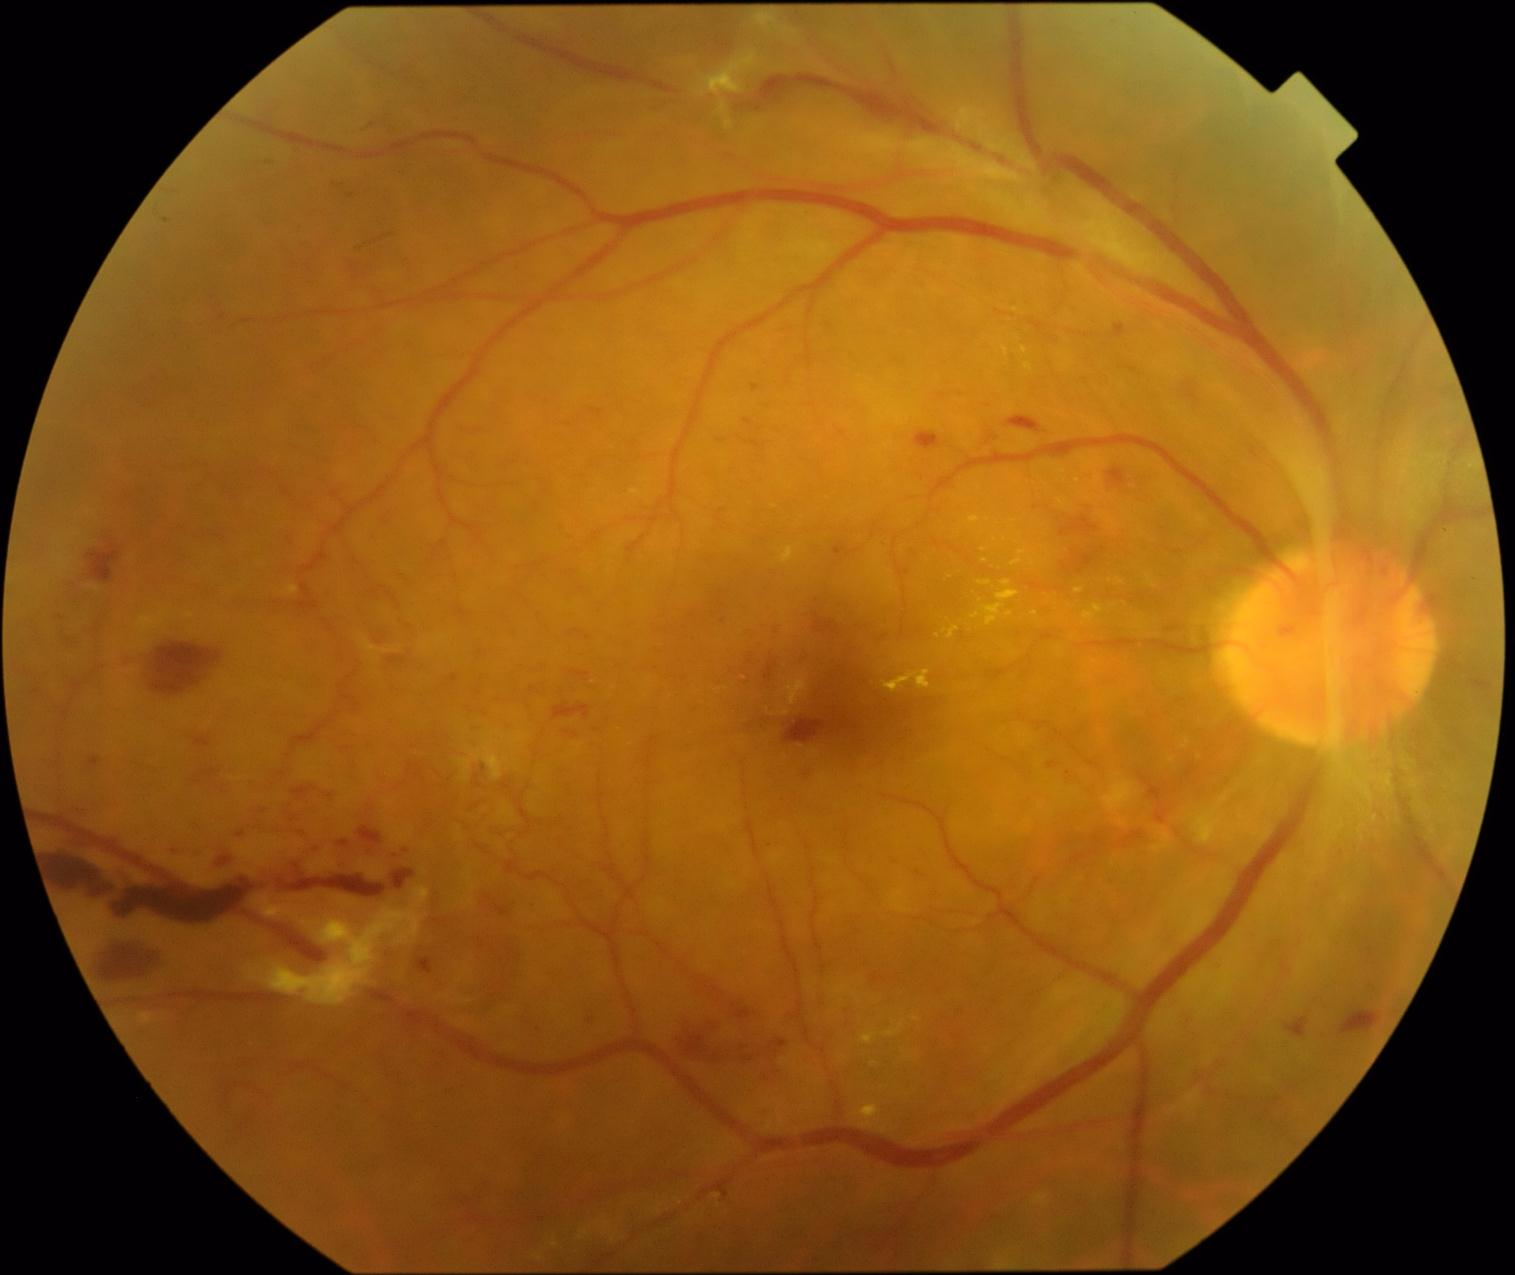
{"partial":true,"dr_grade":4,"dr_grade_name":"PDR","lesions":{"he":[[44,853,115,904],[588,1016,598,1029],[1250,448,1259,459],[84,544,121,587],[711,1182,737,1204],[194,737,216,750],[1115,325,1127,339],[1150,786,1168,825],[118,876,262,931],[915,434,942,451],[1119,834,1144,850],[977,421,1003,454],[333,861,350,875],[232,832,247,845],[799,764,815,785],[1008,418,1041,434]],"he_small_centers":[[1052,766]],"ex":[[1019,551,1027,556],[883,672,931,694],[1116,579,1124,585],[1147,576,1155,588],[978,582,993,587],[778,547,795,565],[283,587,300,595],[184,612,195,619]],"ex_small_centers":[[901,661],[1014,521],[985,561],[1110,582],[1009,615],[938,636]]}}